Image size 848x848. Modified Davis grading: 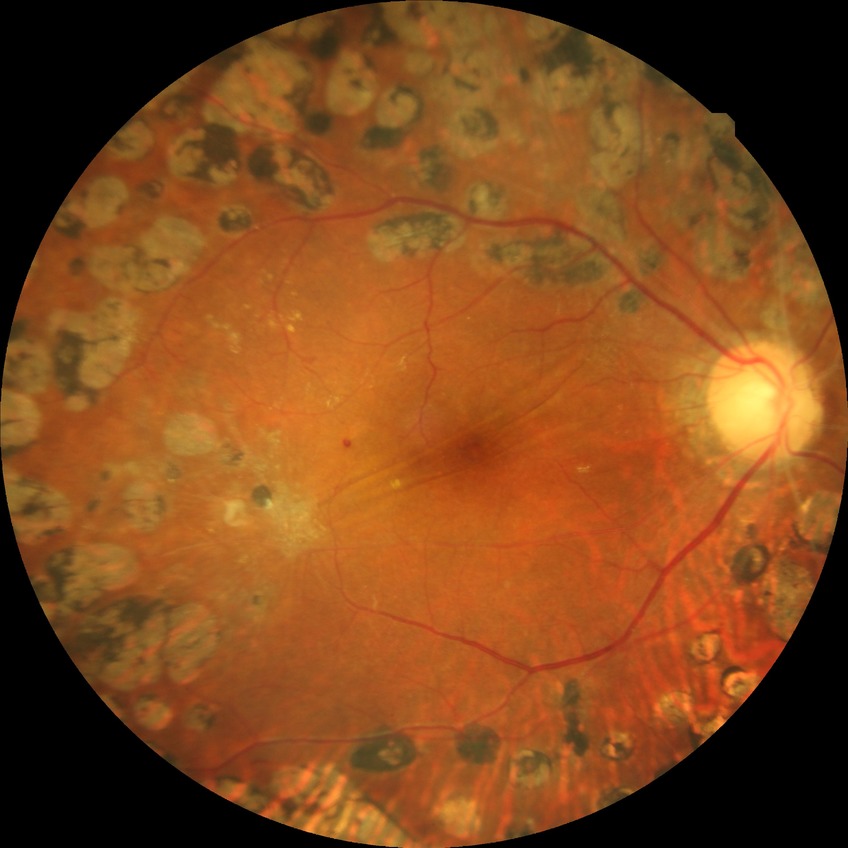 Modified Davis classification: proliferative diabetic retinopathy.